Pediatric retinal photograph (wide-field).
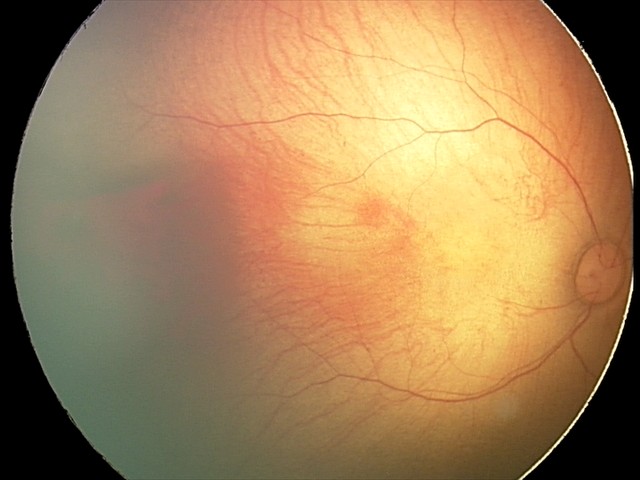

Screening diagnosis: retinal hemorrhages.